FOV: 45 degrees, color fundus photograph, 2212x1659: 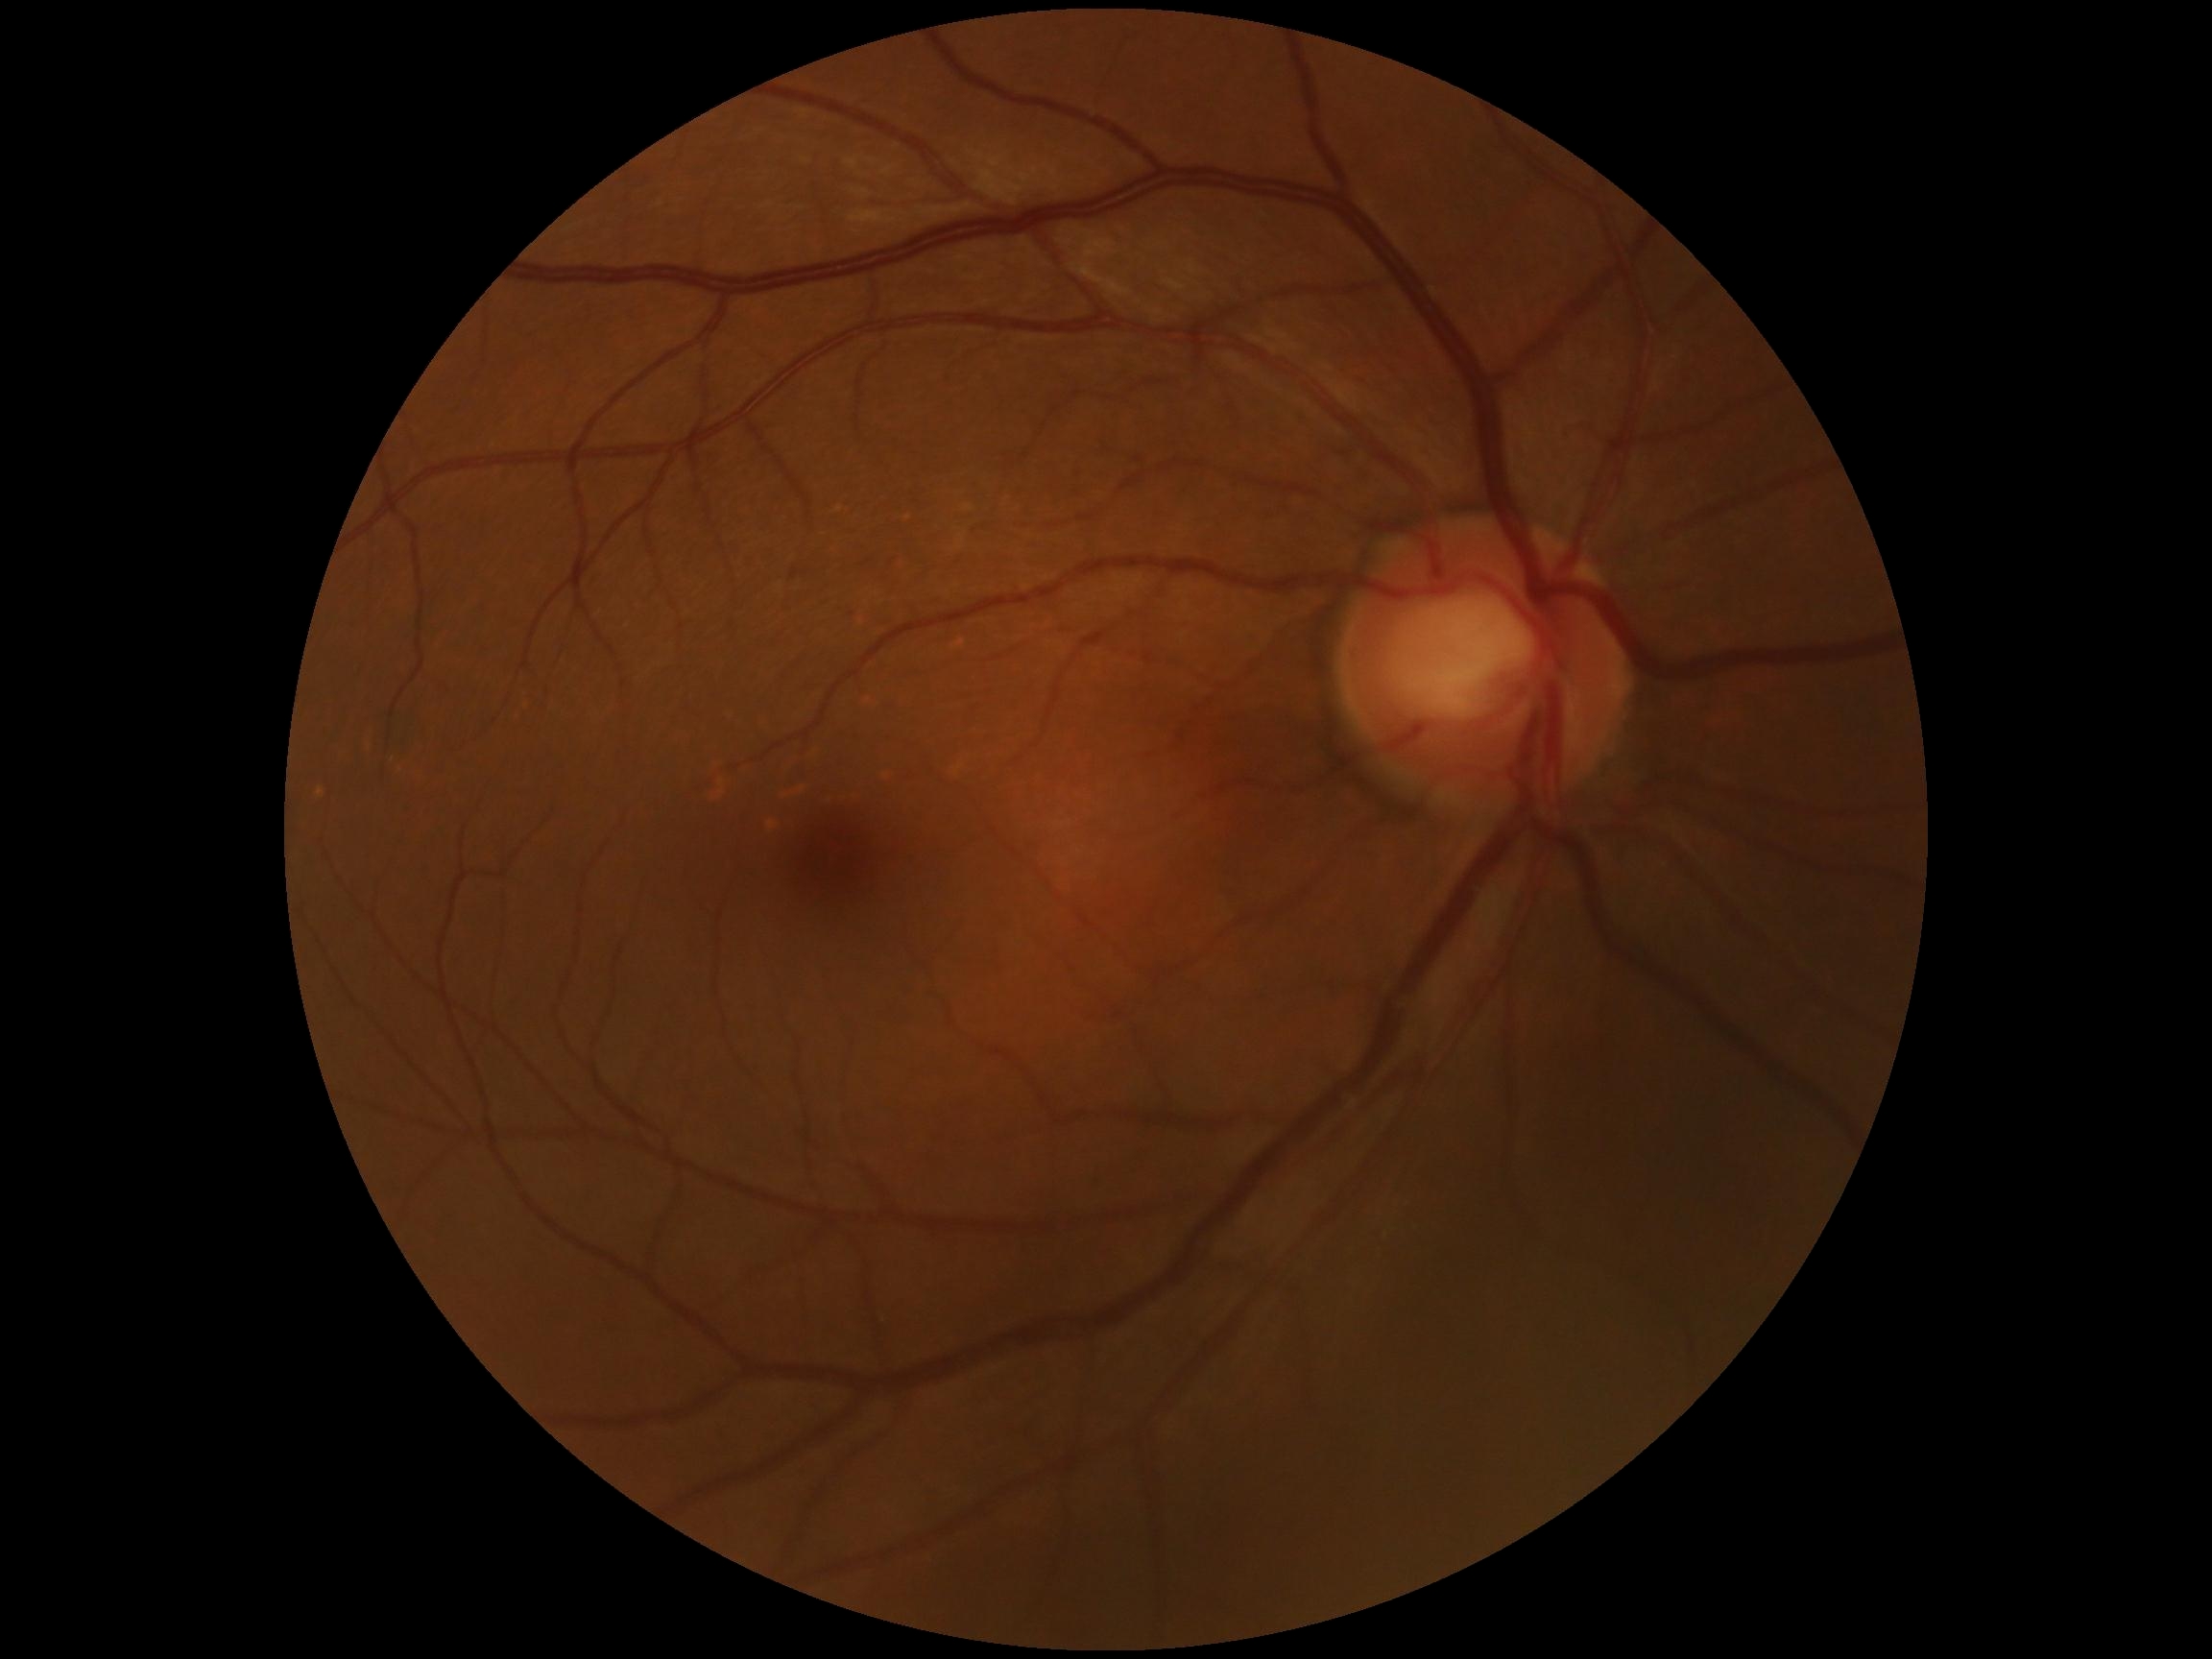

  dr_grade: 0/4 — no visible signs of diabetic retinopathy